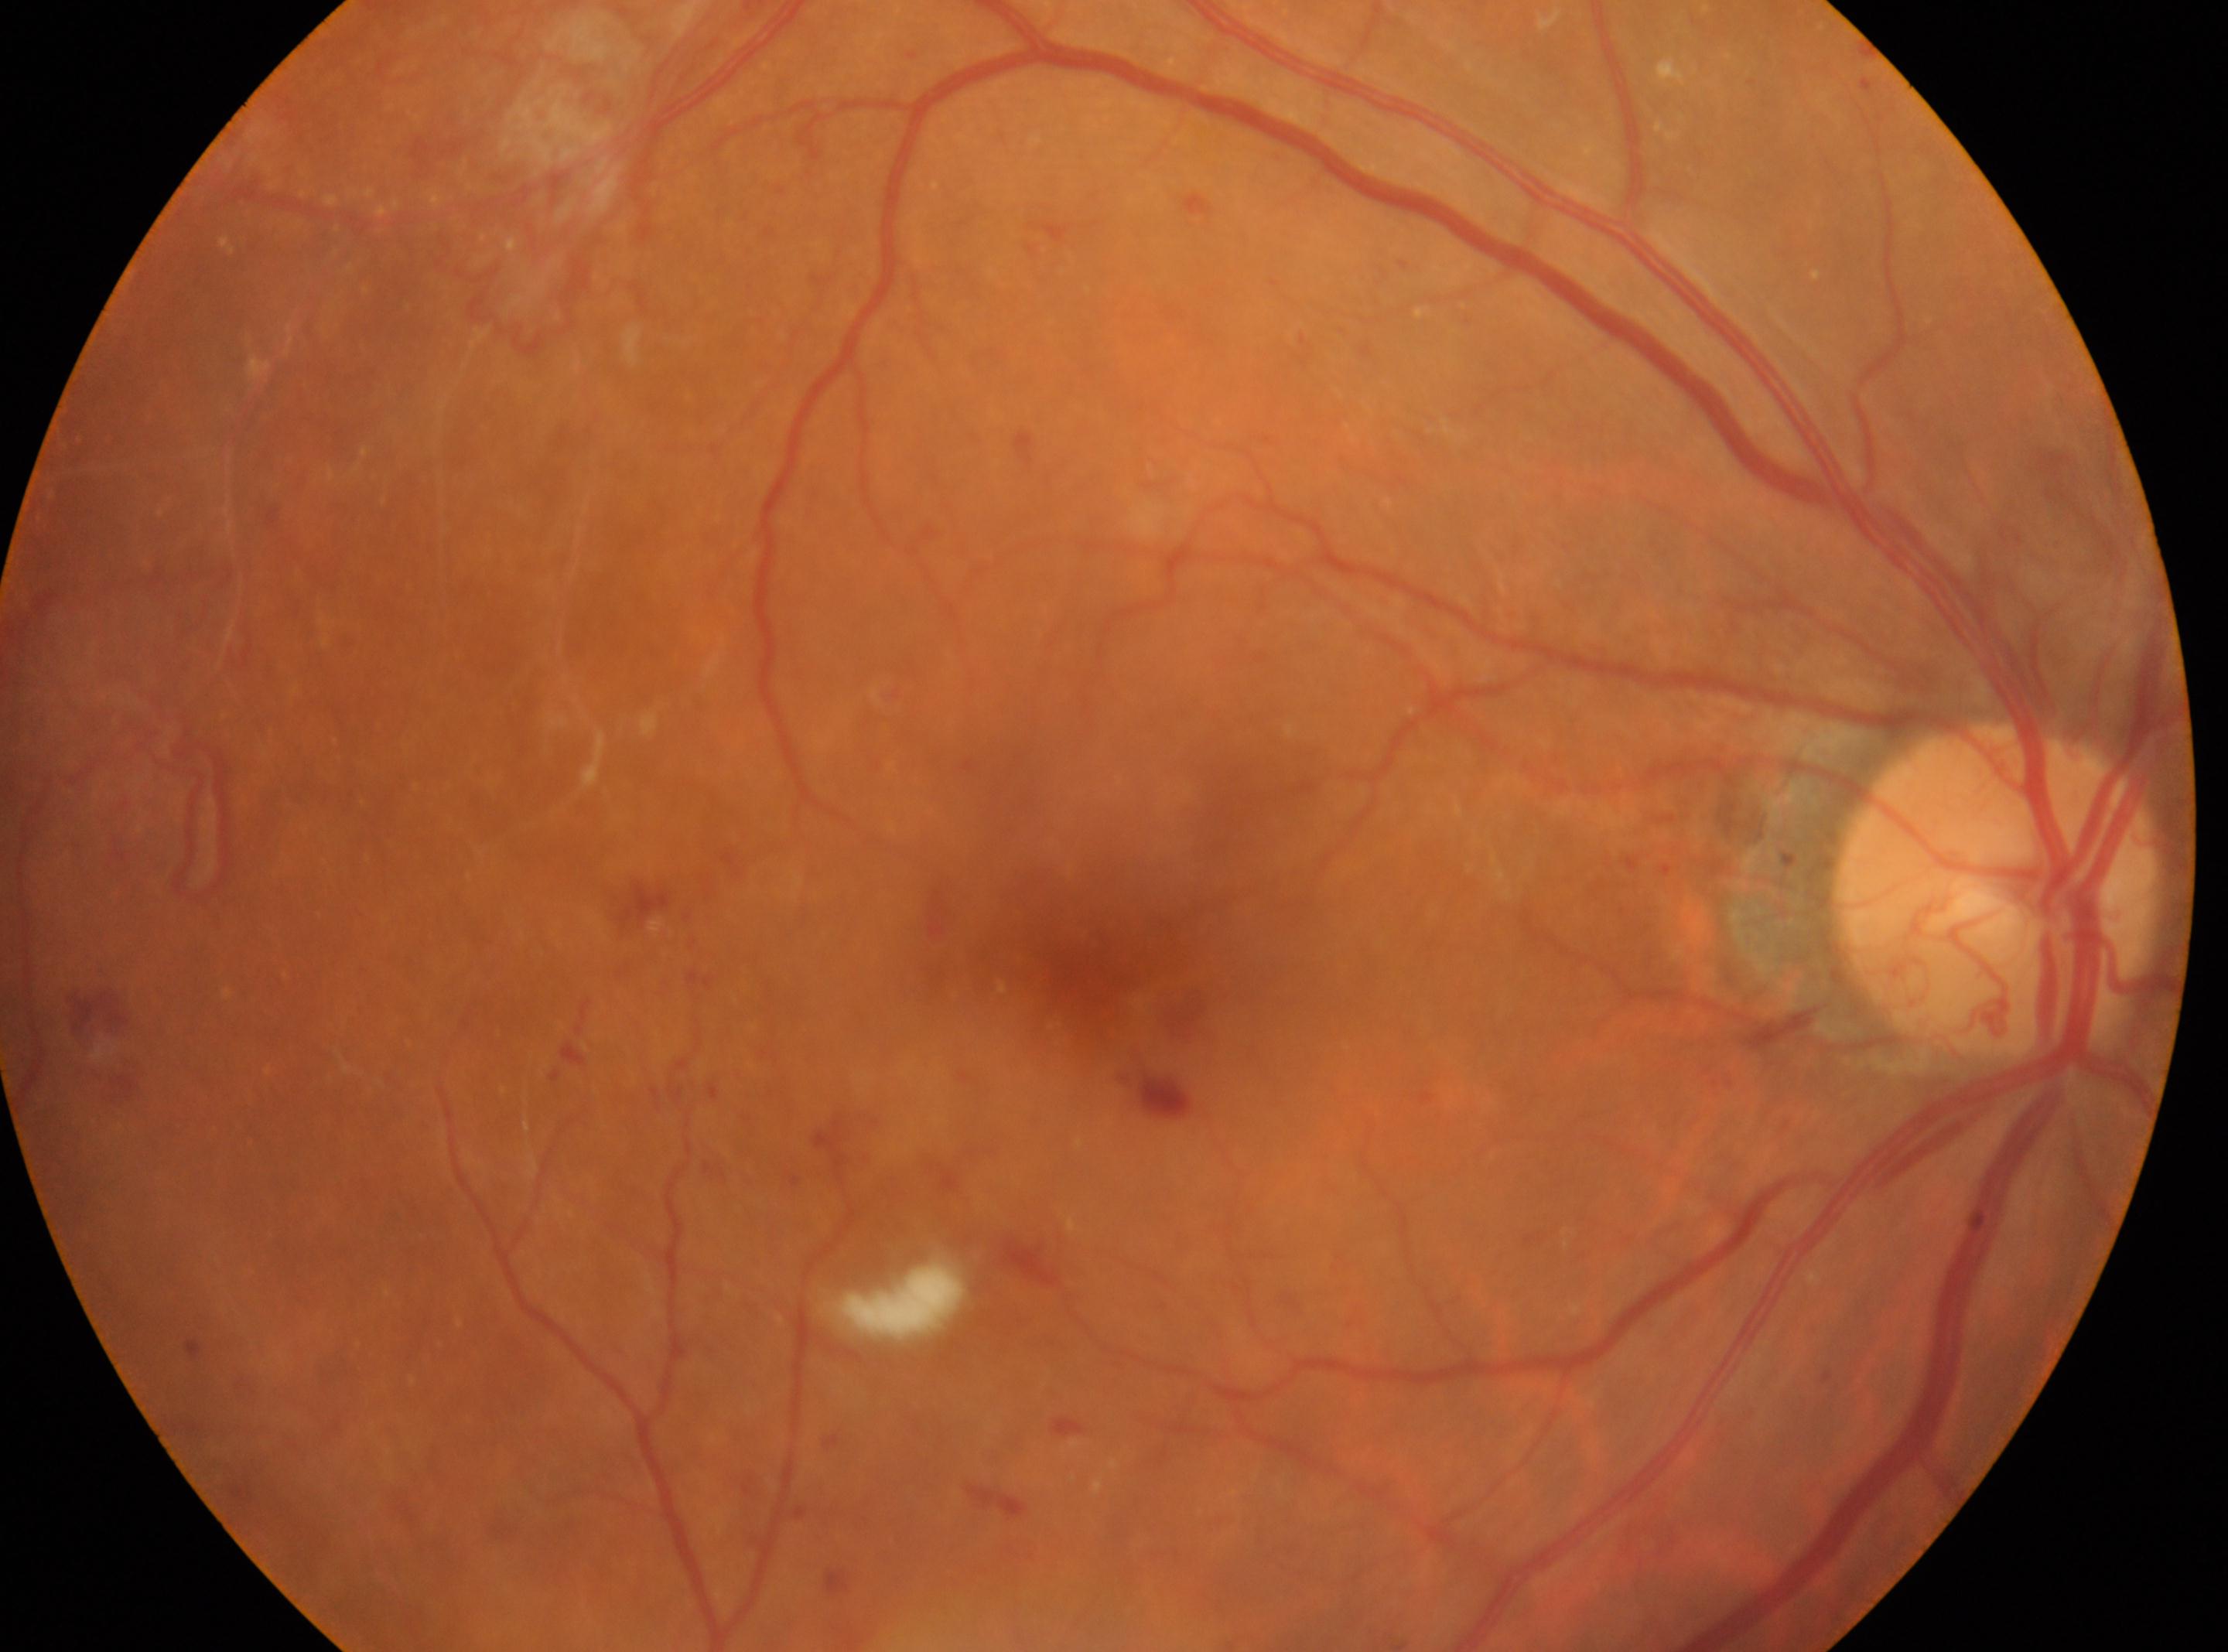 macular center = (1094,937), optic disk = (1996,889), laterality = oculus dexter, diabetic retinopathy grade = 4.